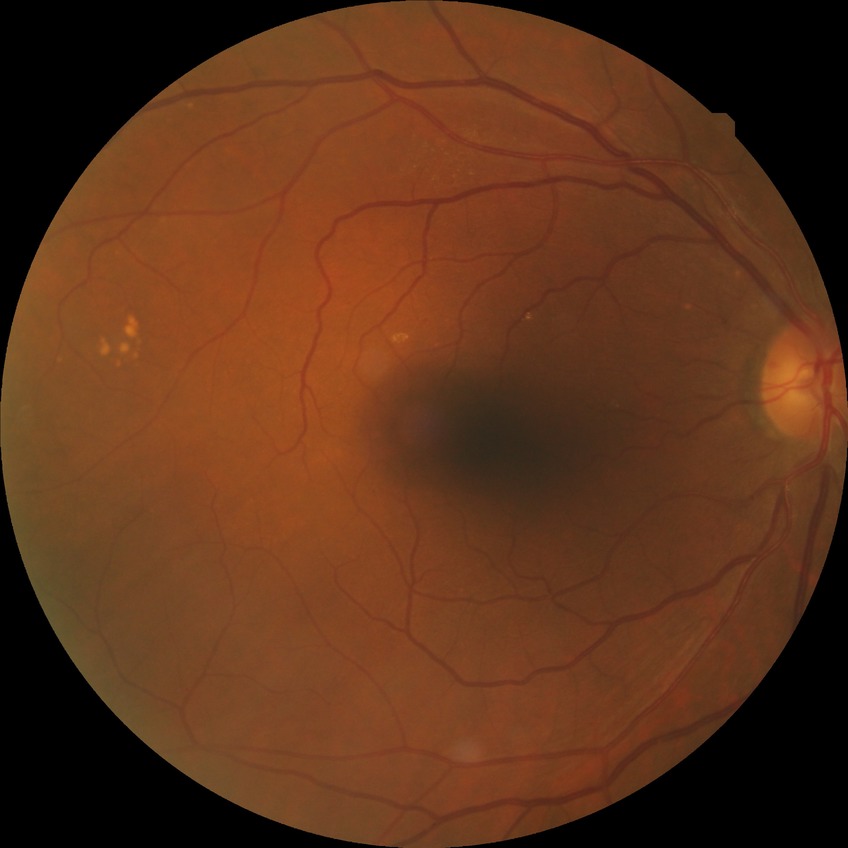

  davis_grade: NDR